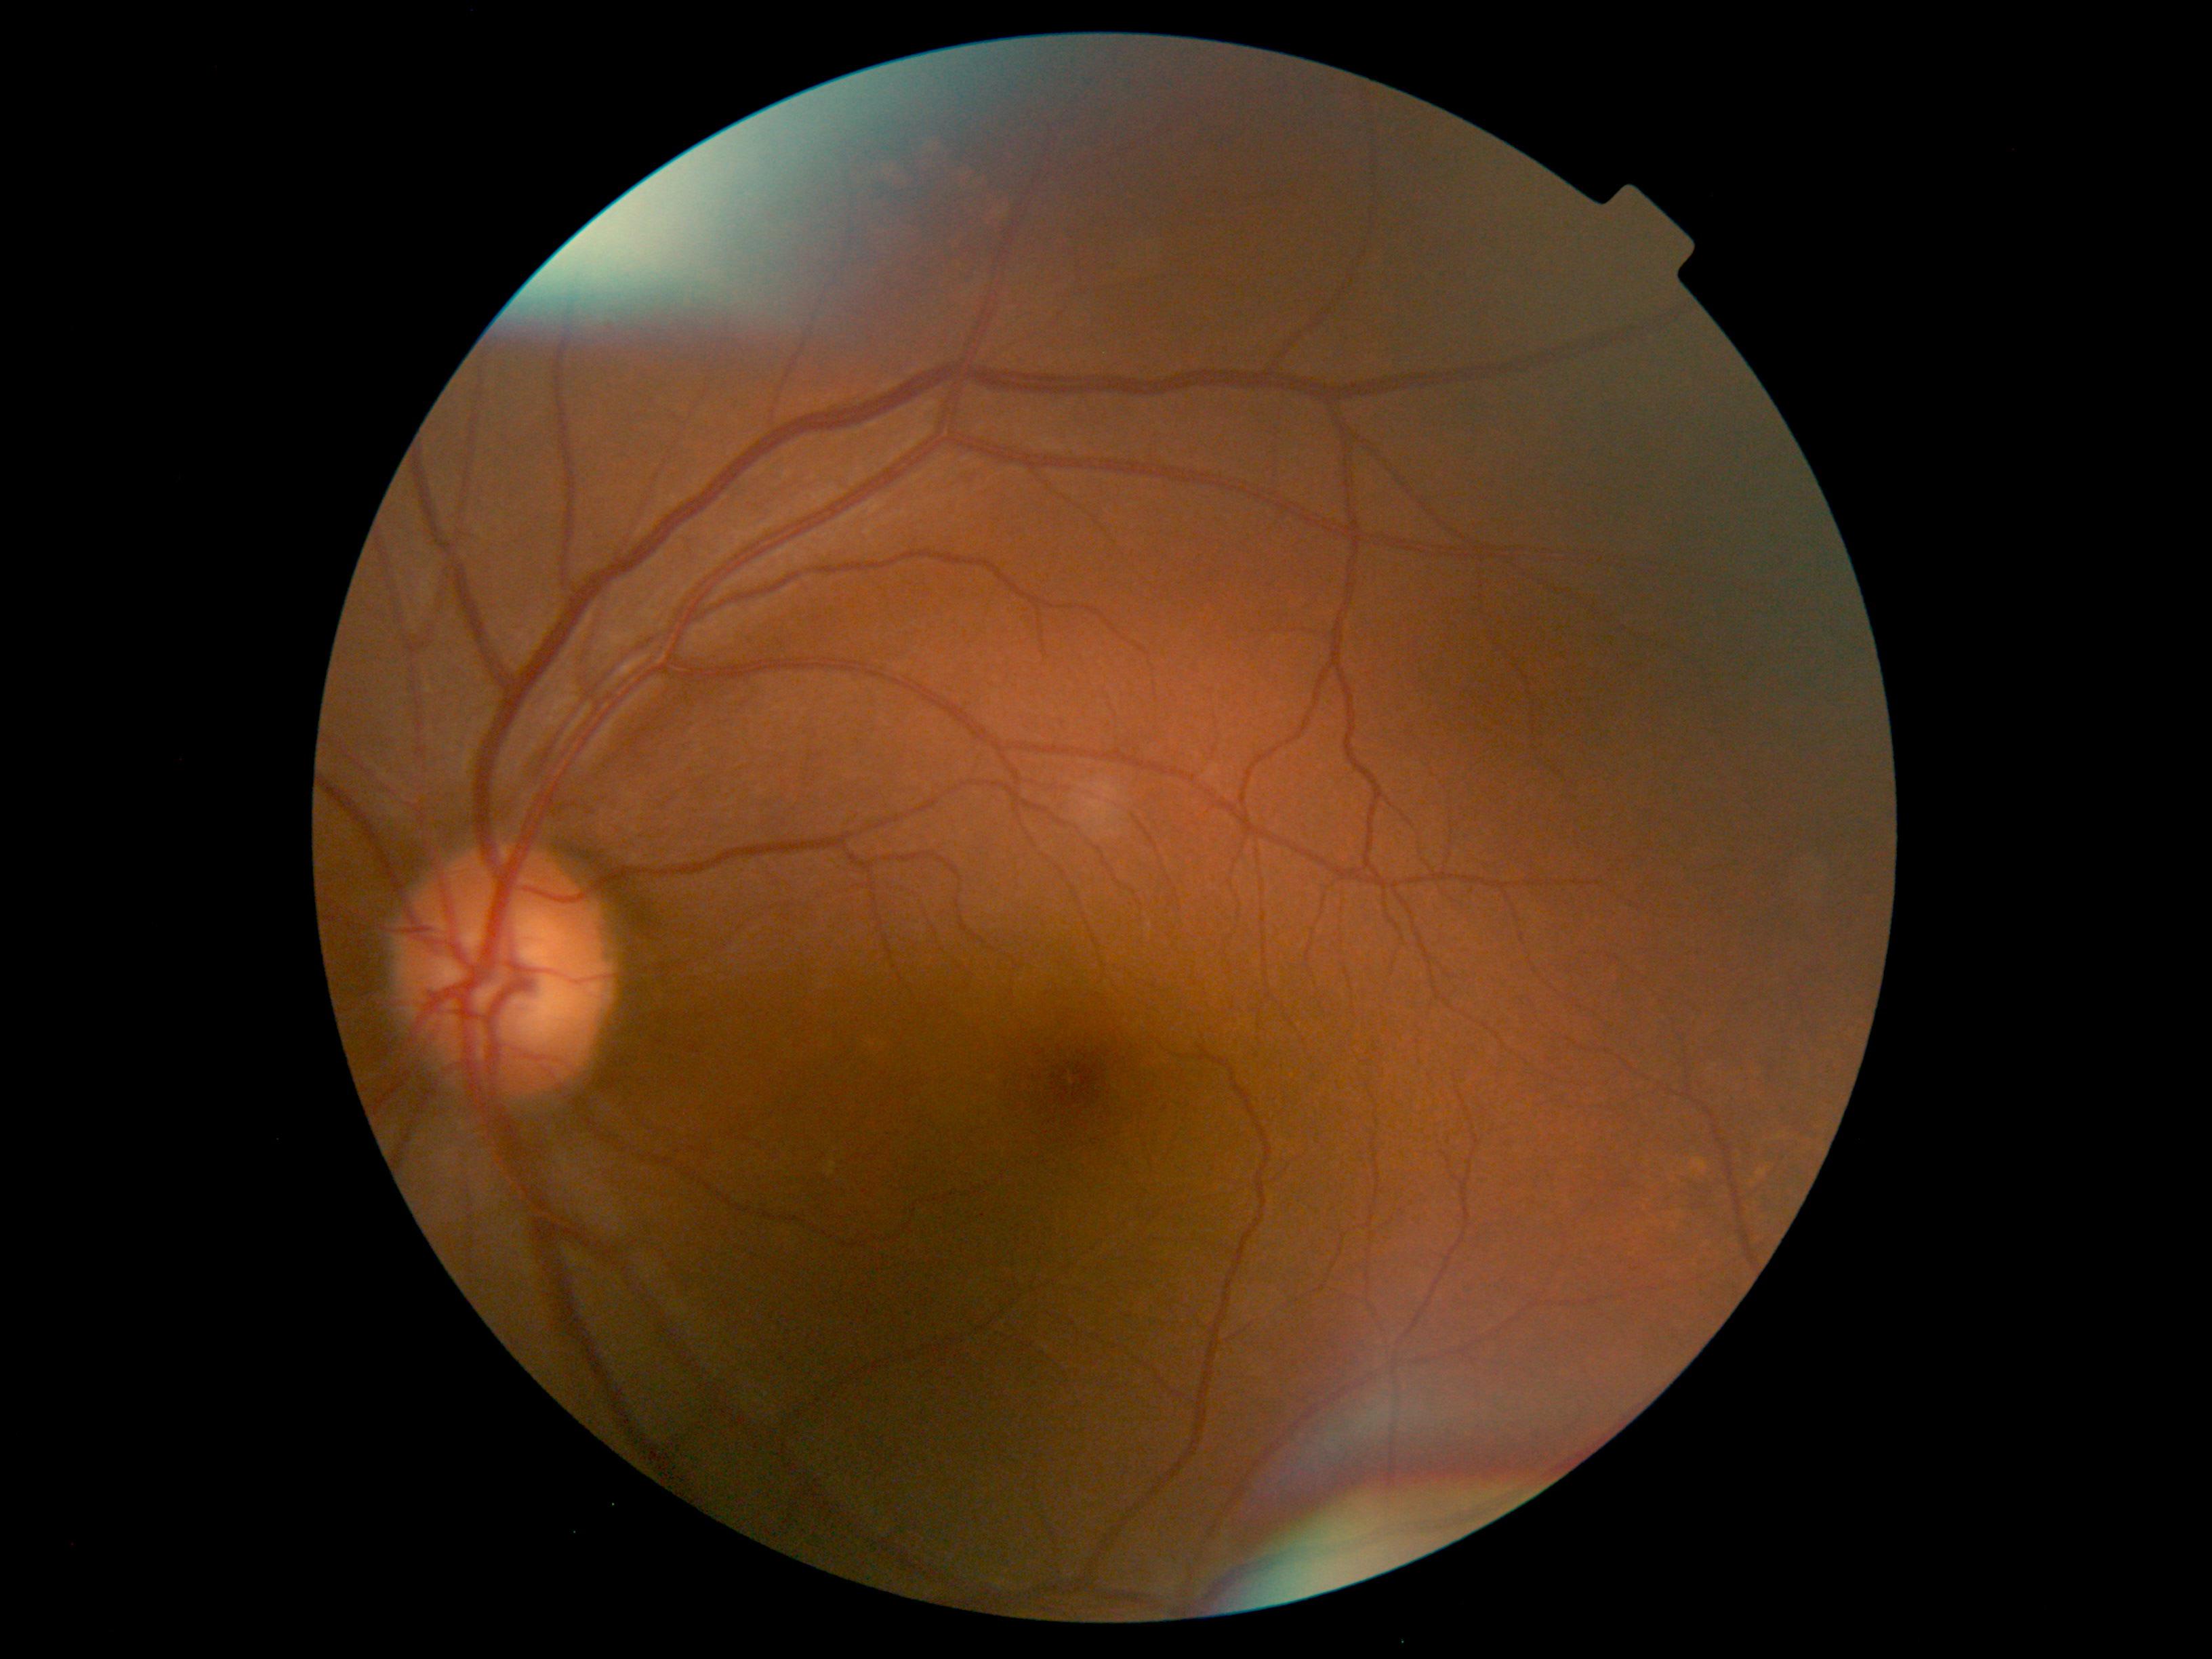

Retinopathy: grade 0 (no apparent retinopathy).